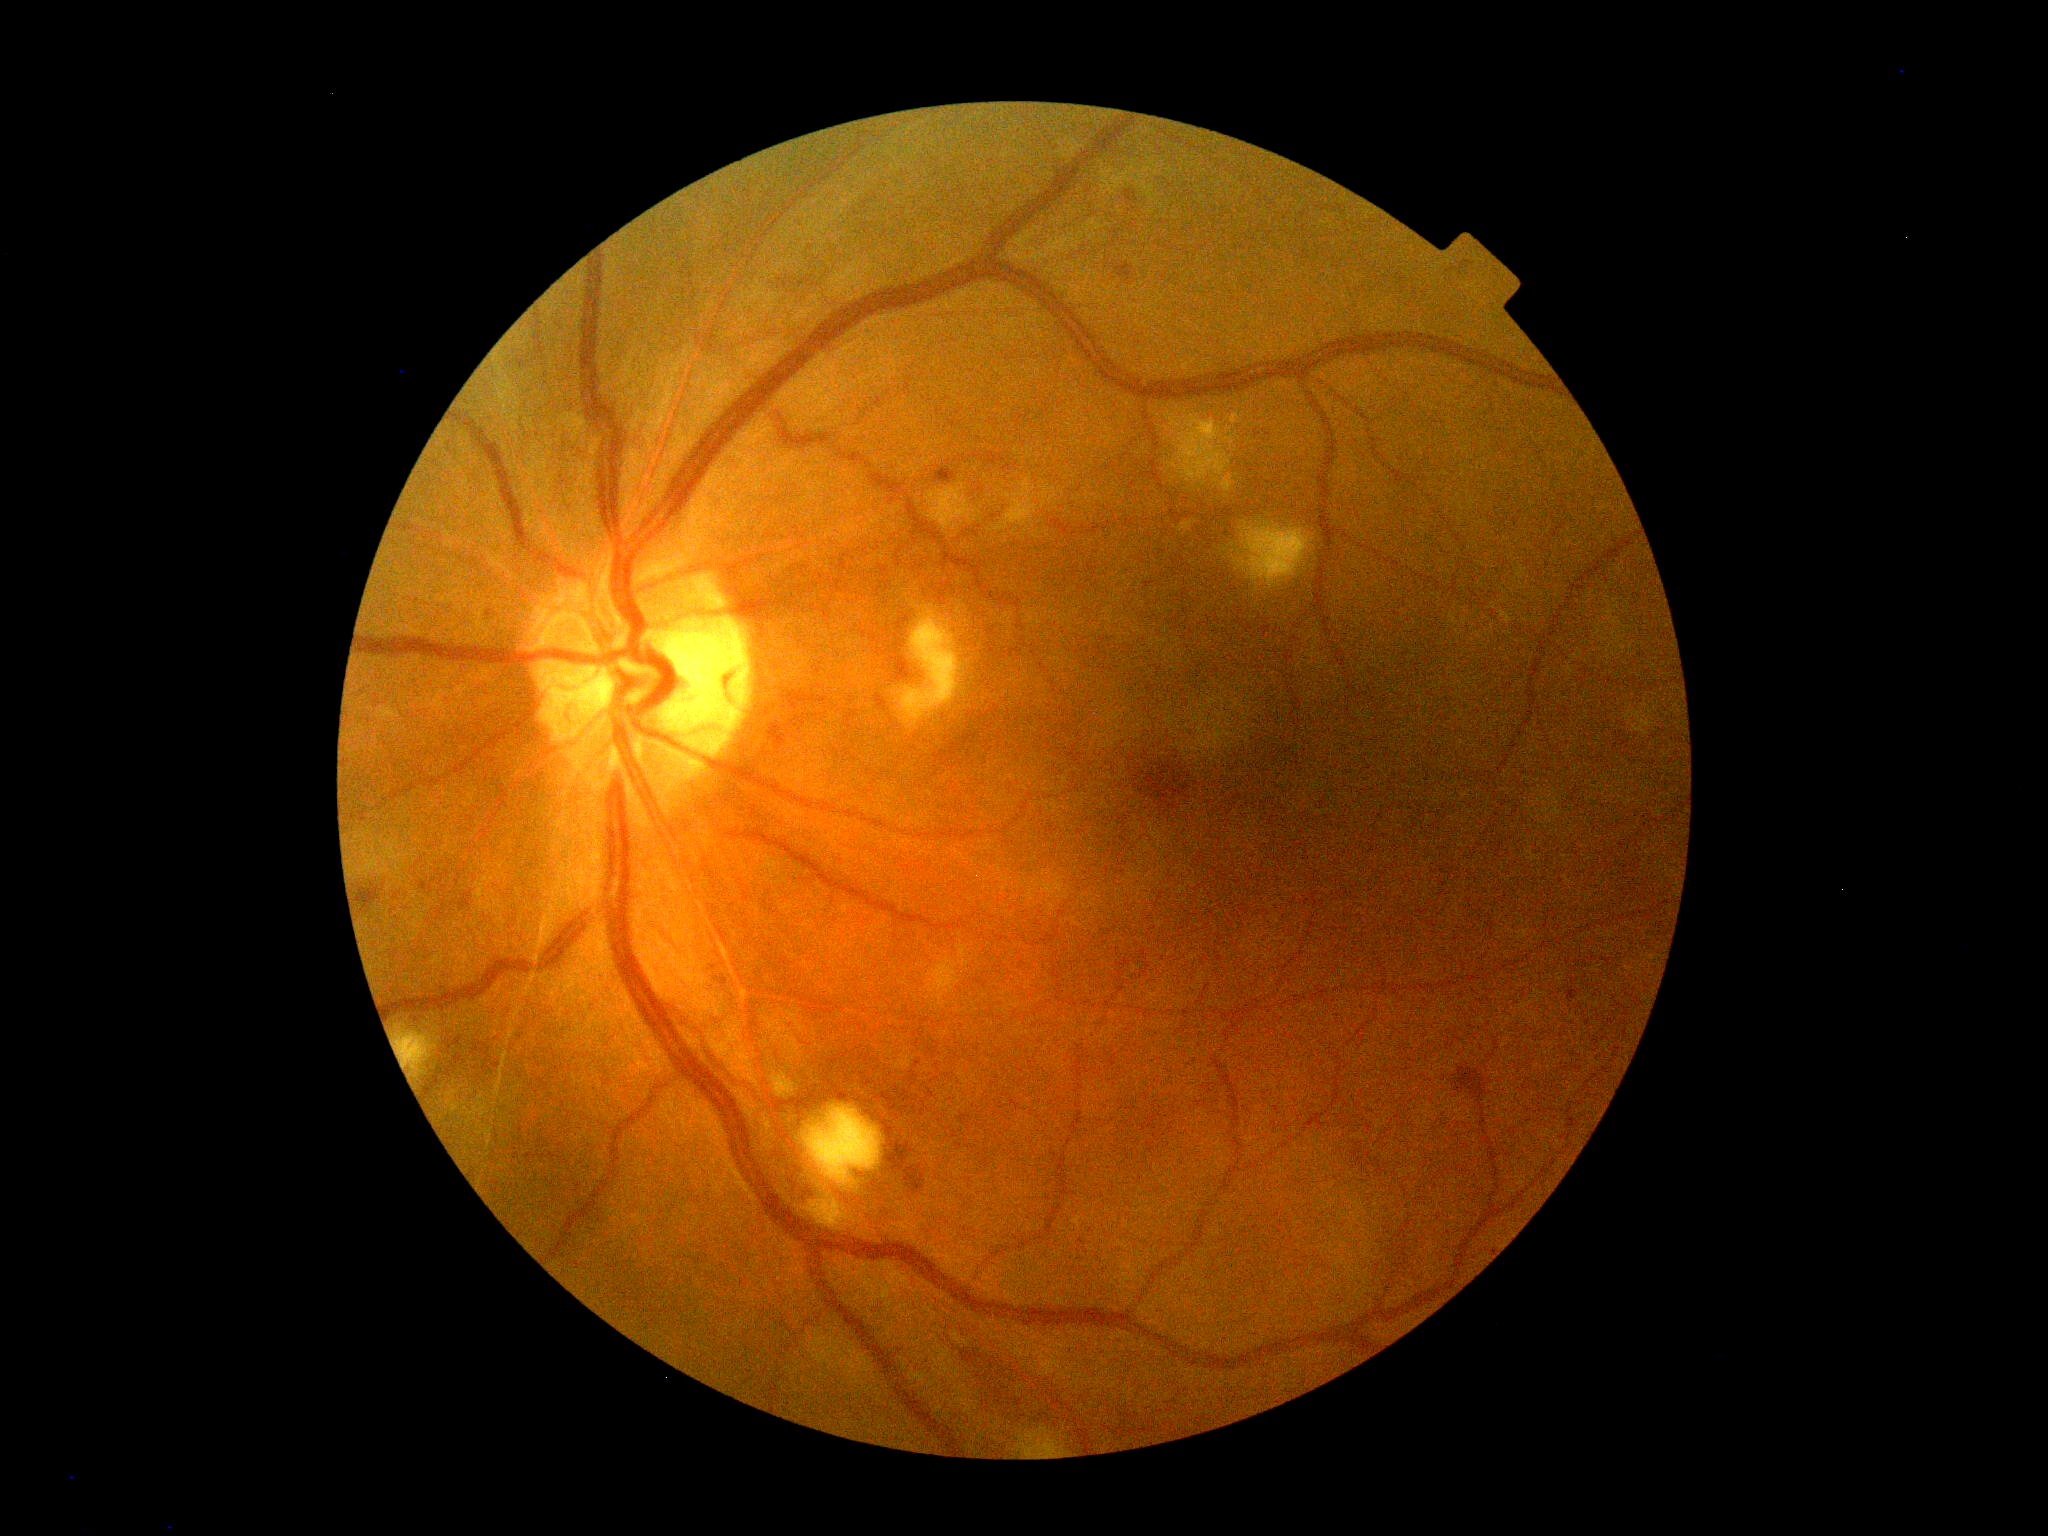
Diabetic retinopathy is grade 2 (moderate NPDR).